Retinal fundus photograph. Nonmydriatic fundus photograph:
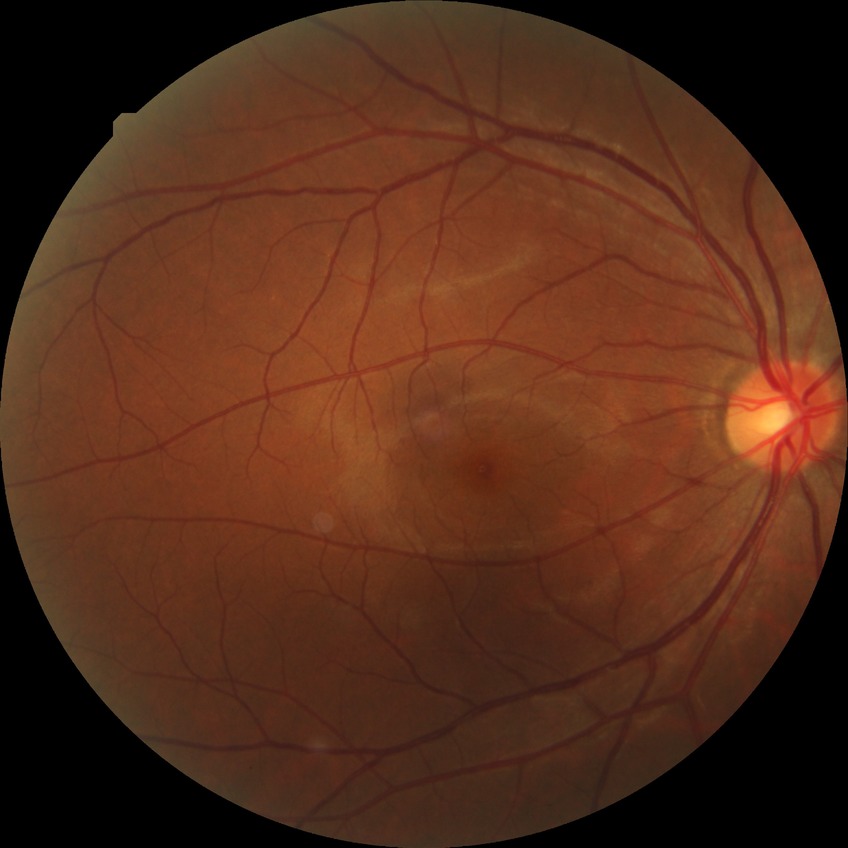

Findings:
- diabetic retinopathy (DR): NDR (no diabetic retinopathy)